45° field of view. CFP. 2352x1568
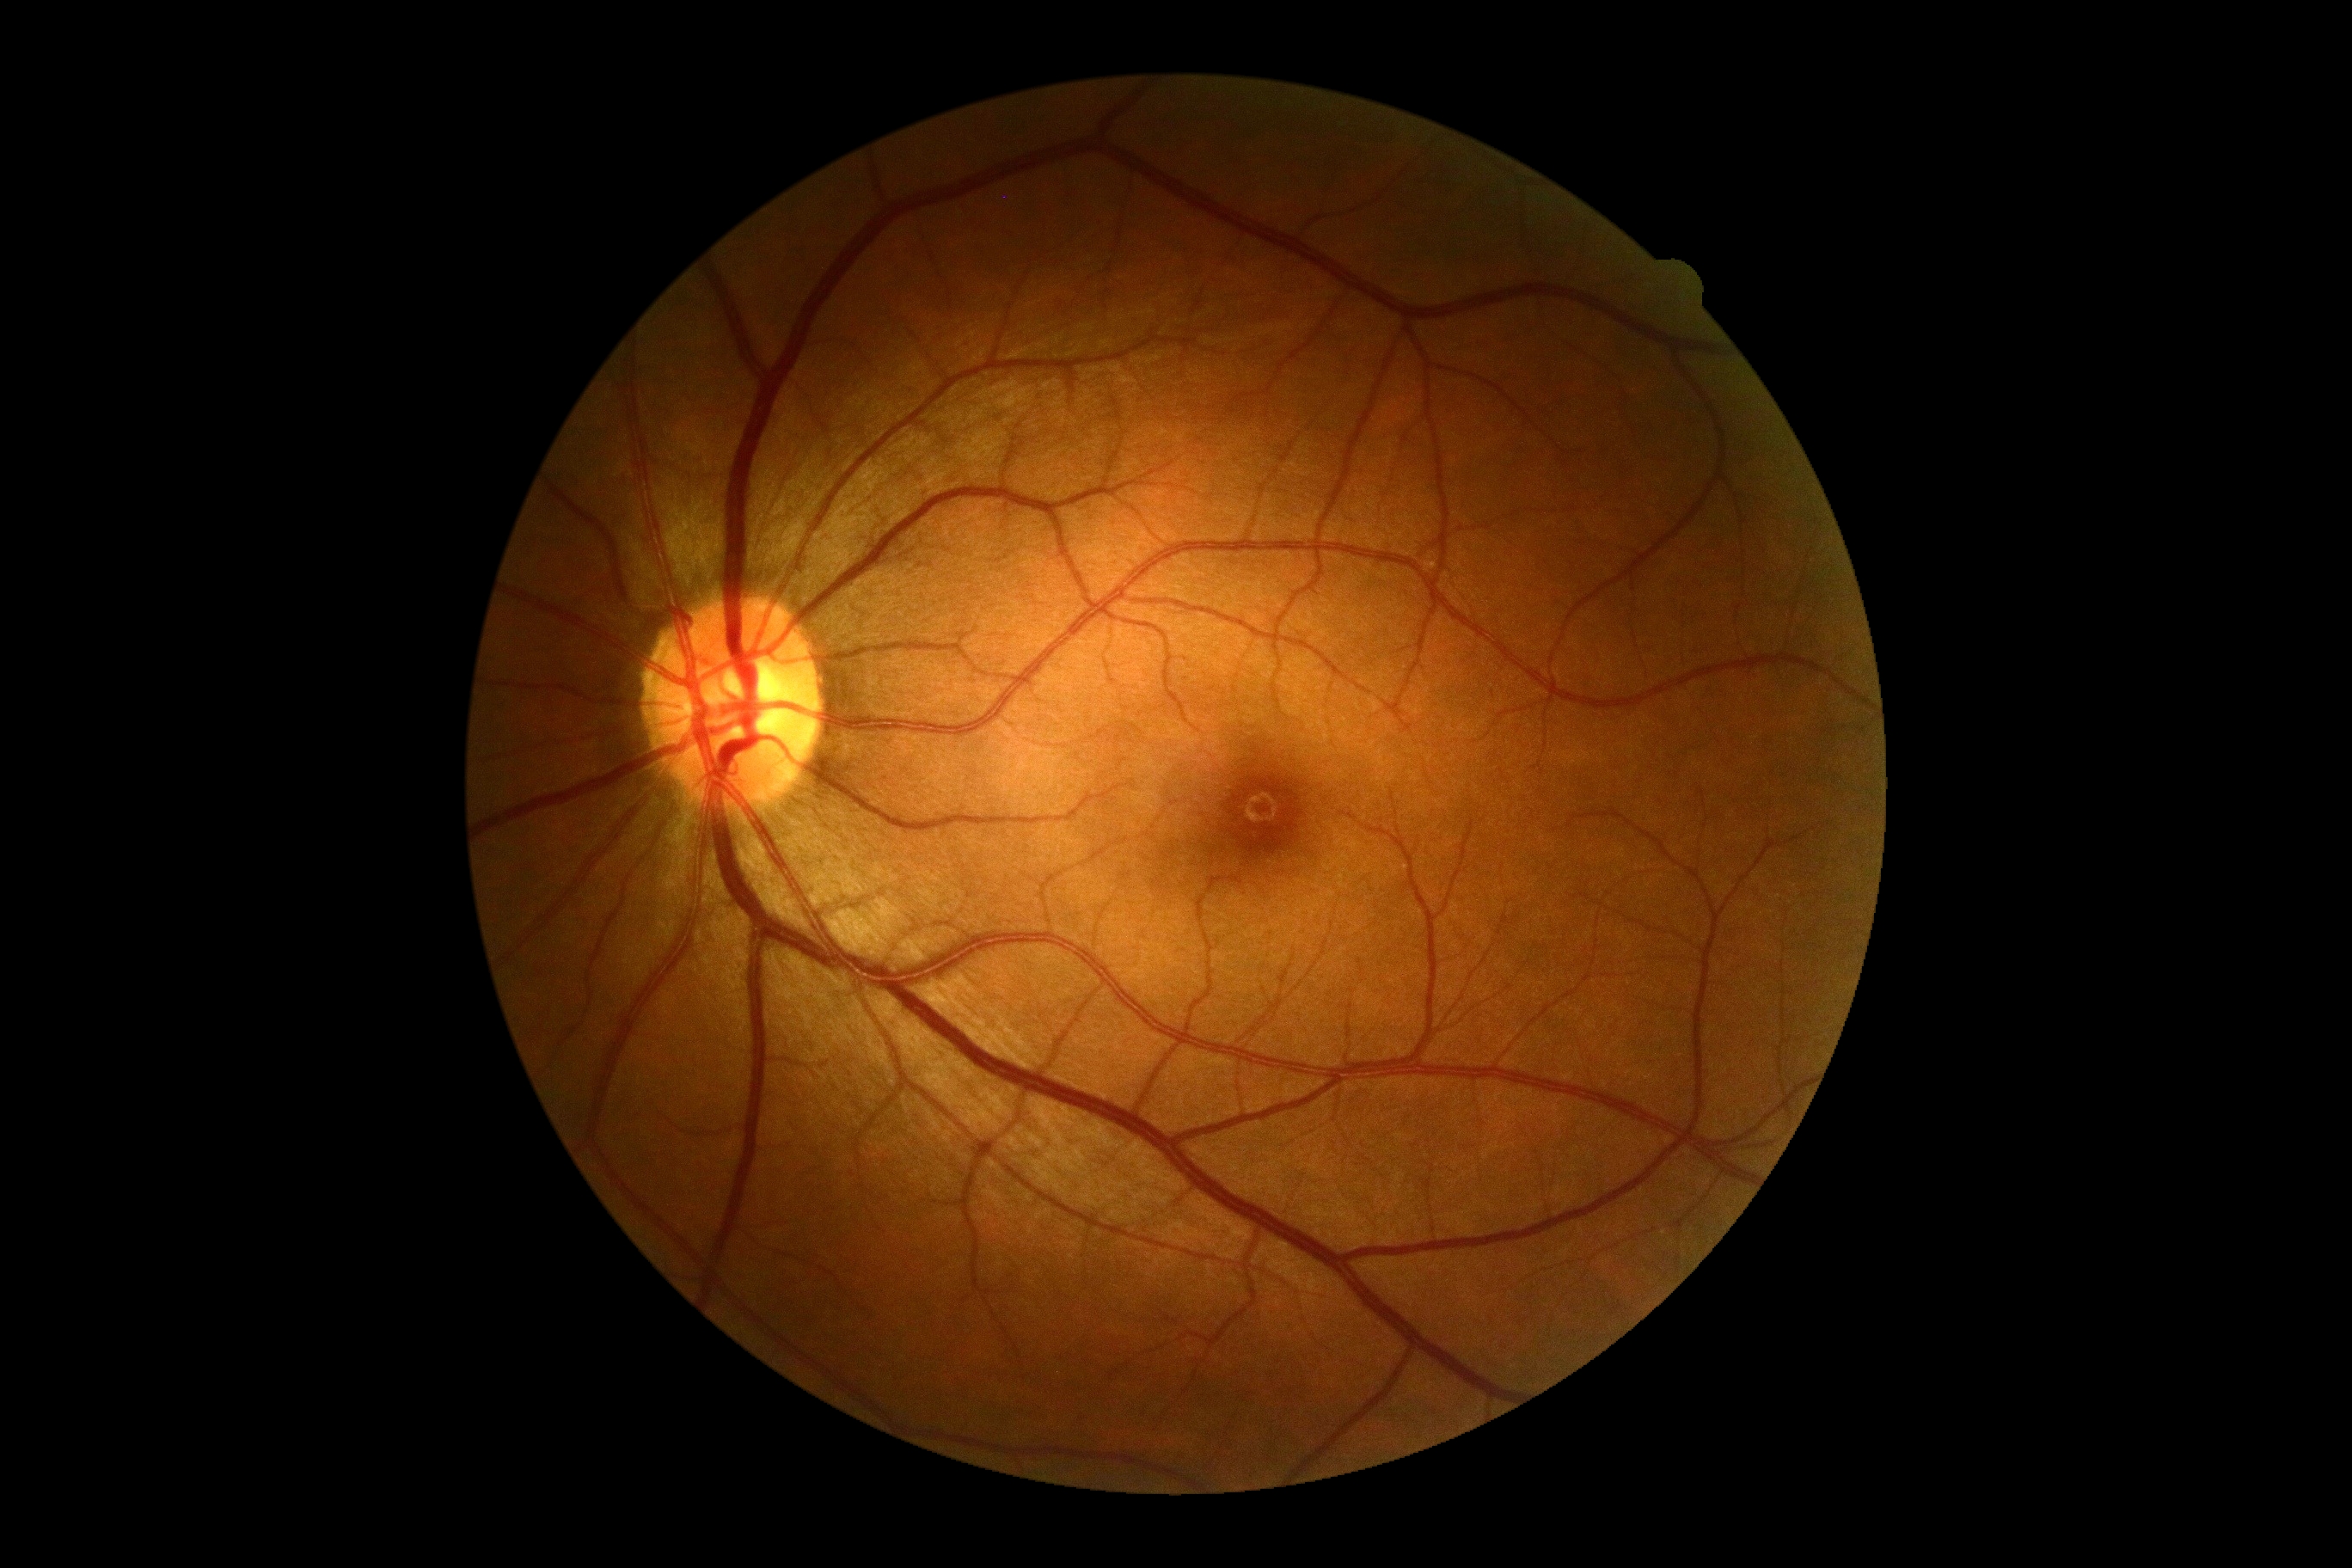
DR stage=no apparent diabetic retinopathy (grade 0); DR impression=negative for DR.